Clarity RetCam 3, 130° FOV · wide-field fundus photograph of an infant: 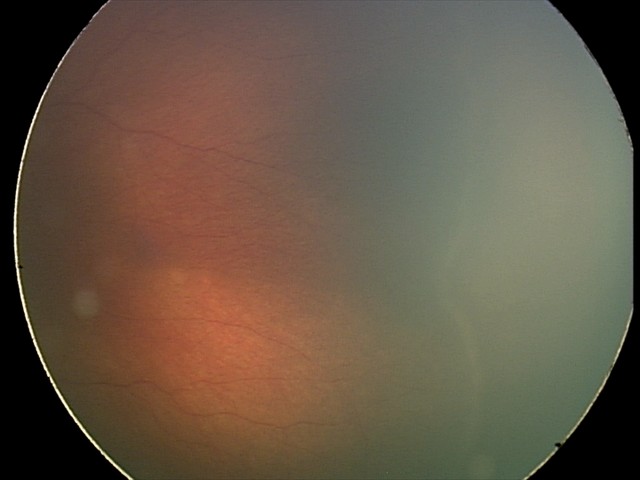
Screening diagnosis = retinopathy of prematurity (ROP) stage 2.